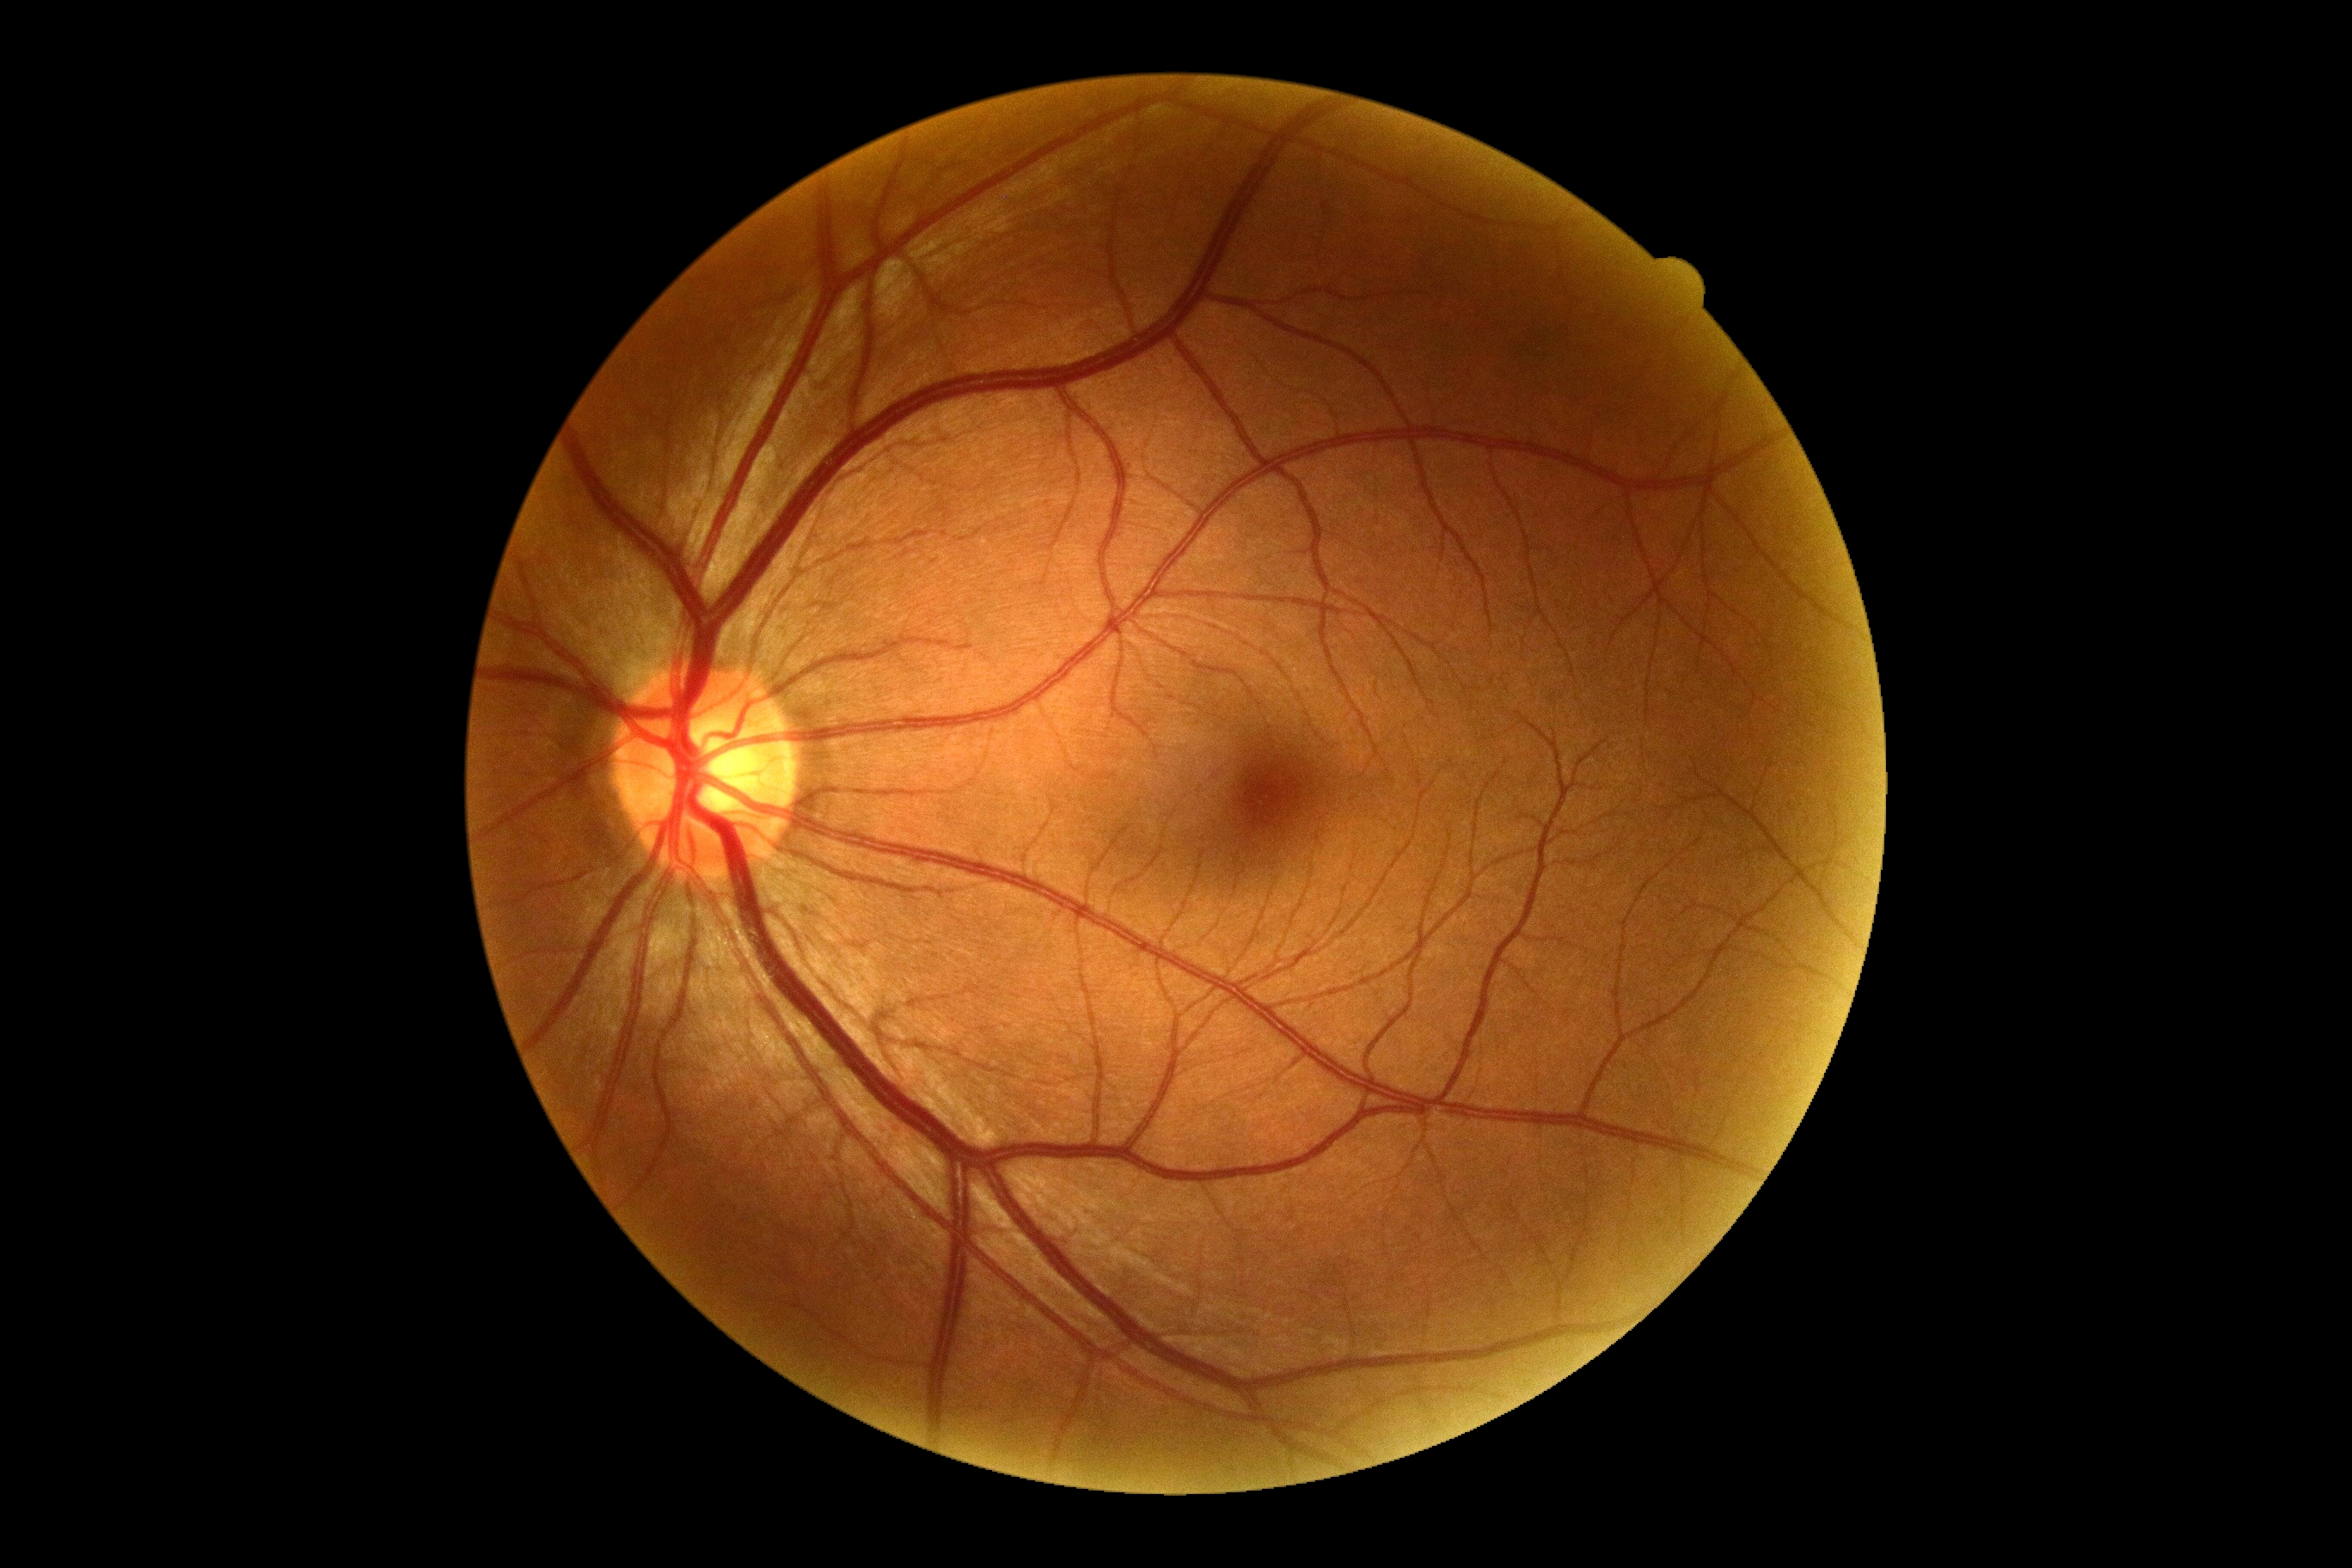
  dr_grade: 0